848 x 848 pixels · nonmydriatic fundus photograph · Davis DR grading · CFP — 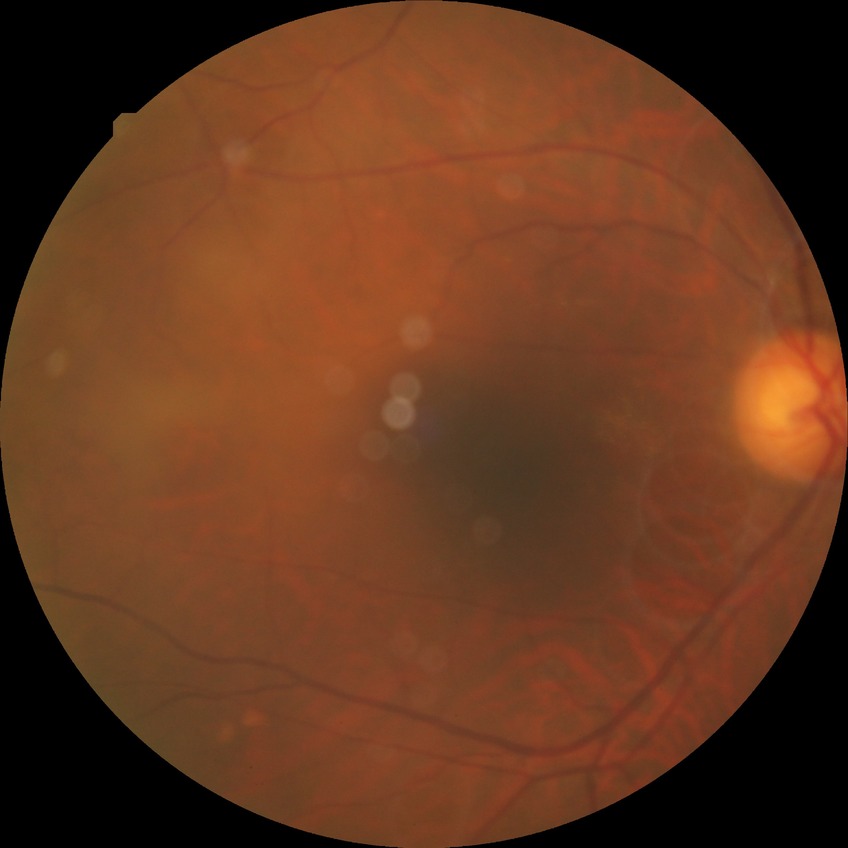

diabetic retinopathy stage: no diabetic retinopathy.